Pediatric wide-field fundus photograph. 1240 x 1240 pixels:
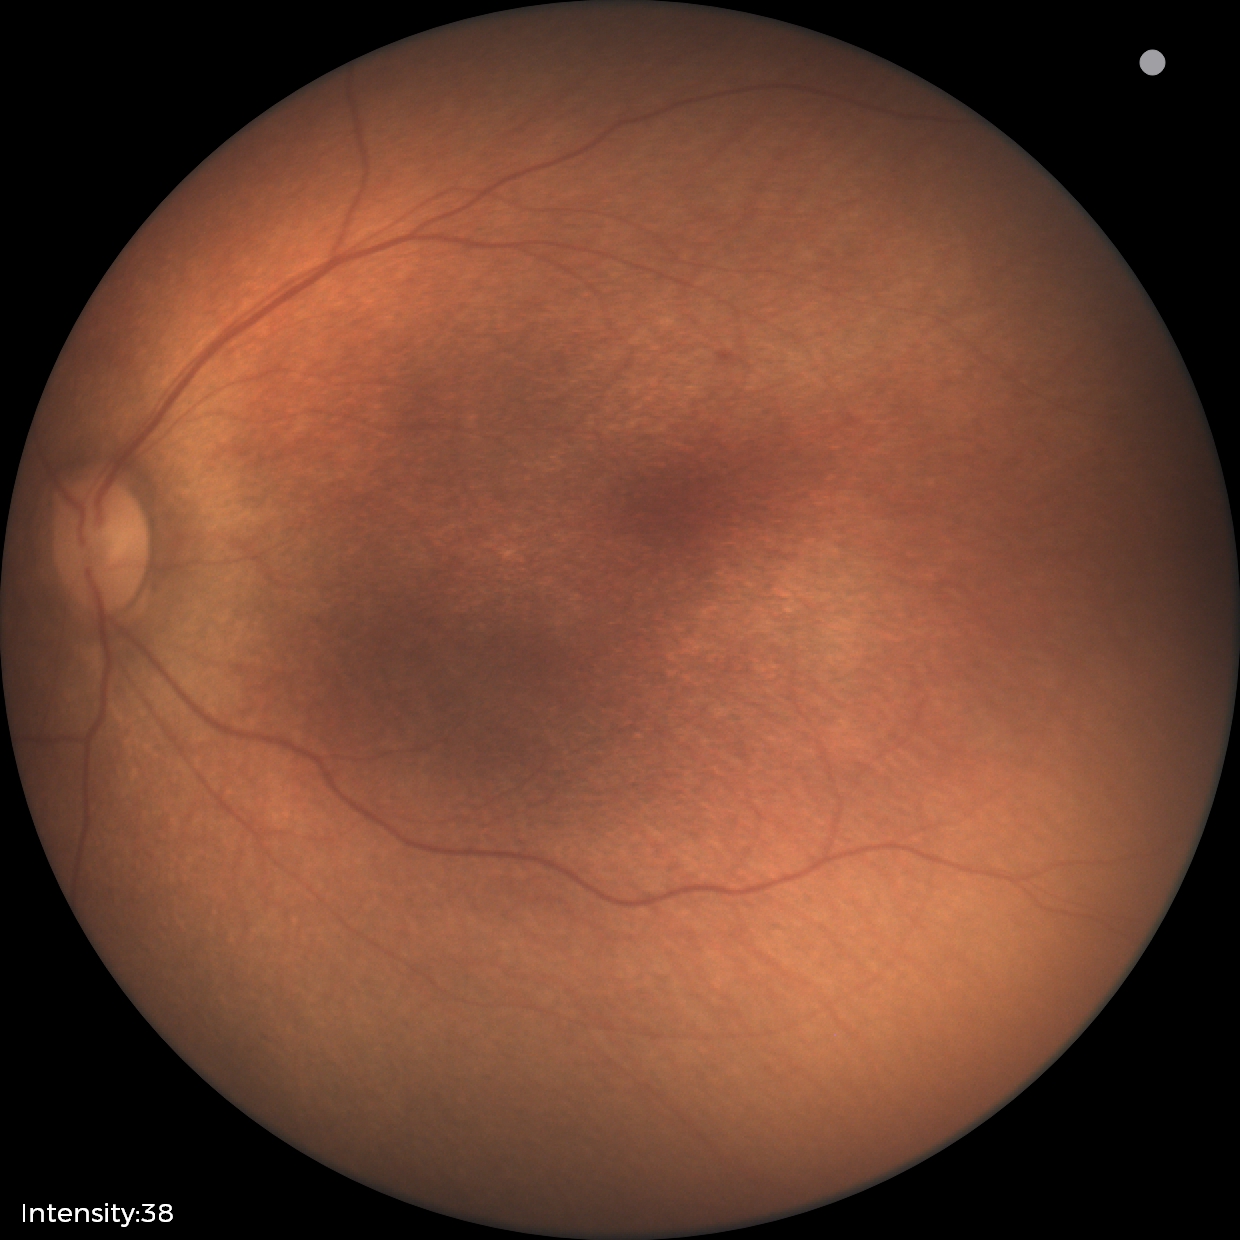

Finding: physiological